45° FOV:
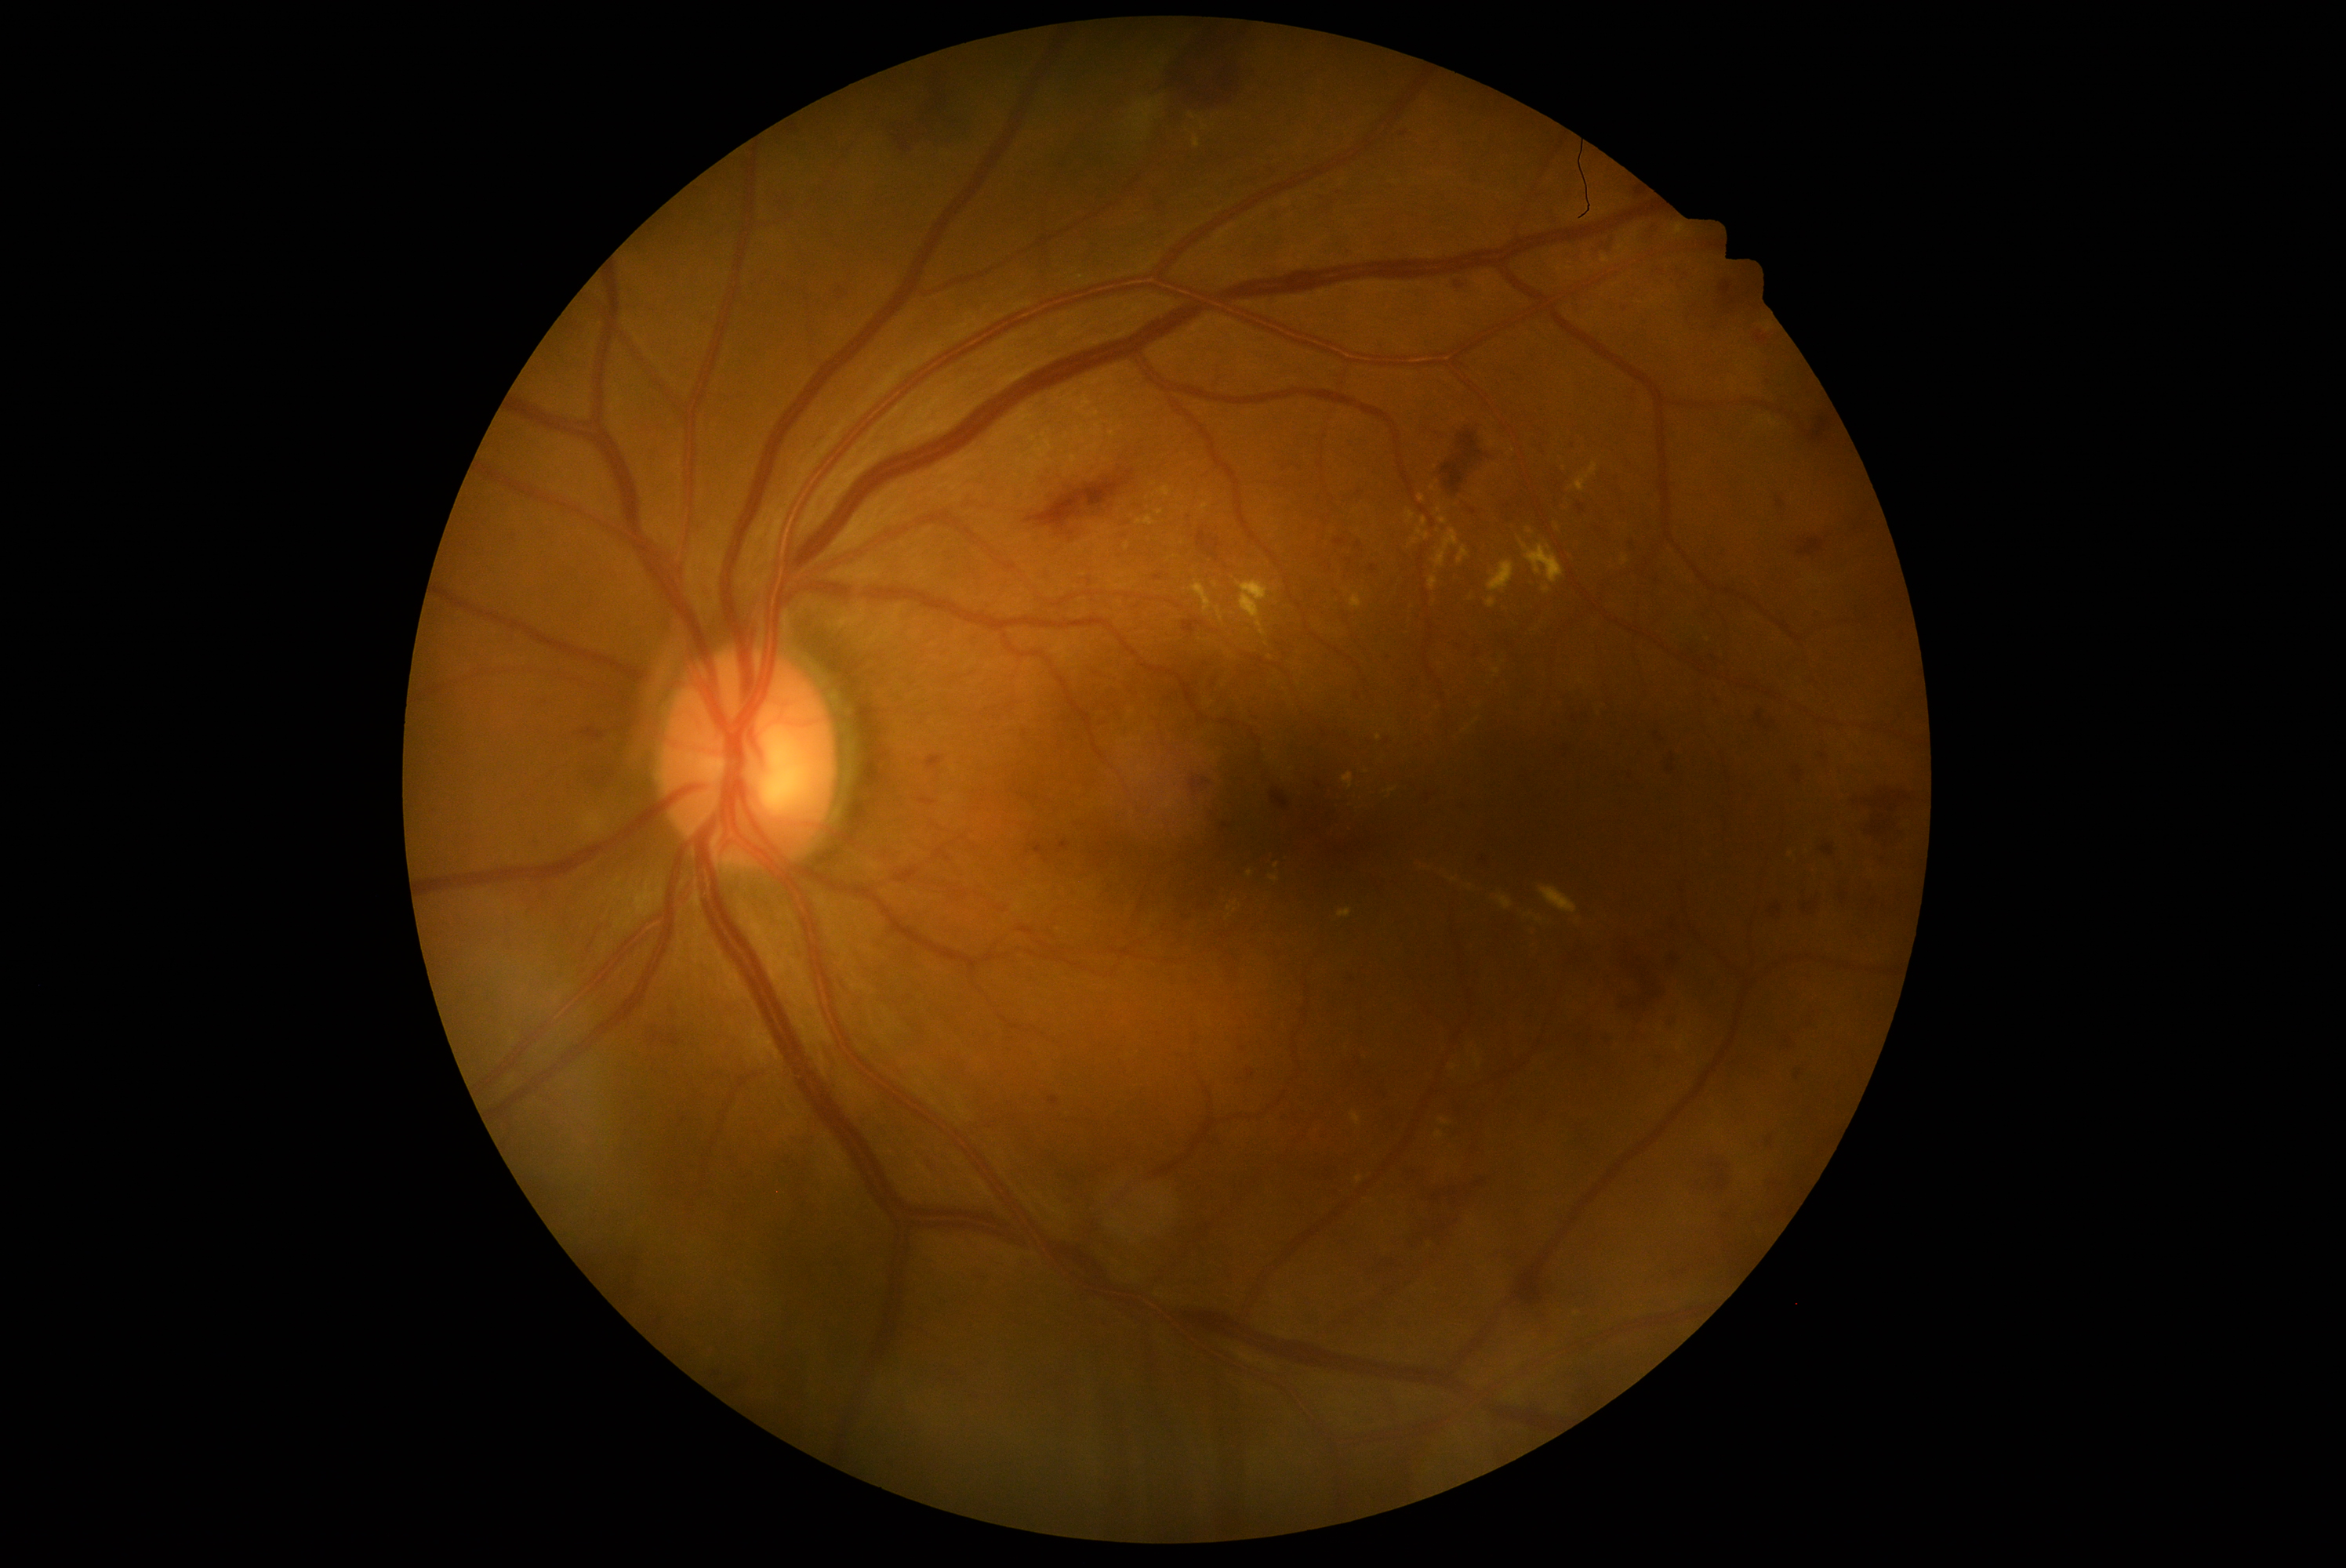
DR stage is severe non-proliferative diabetic retinopathy (grade 3).